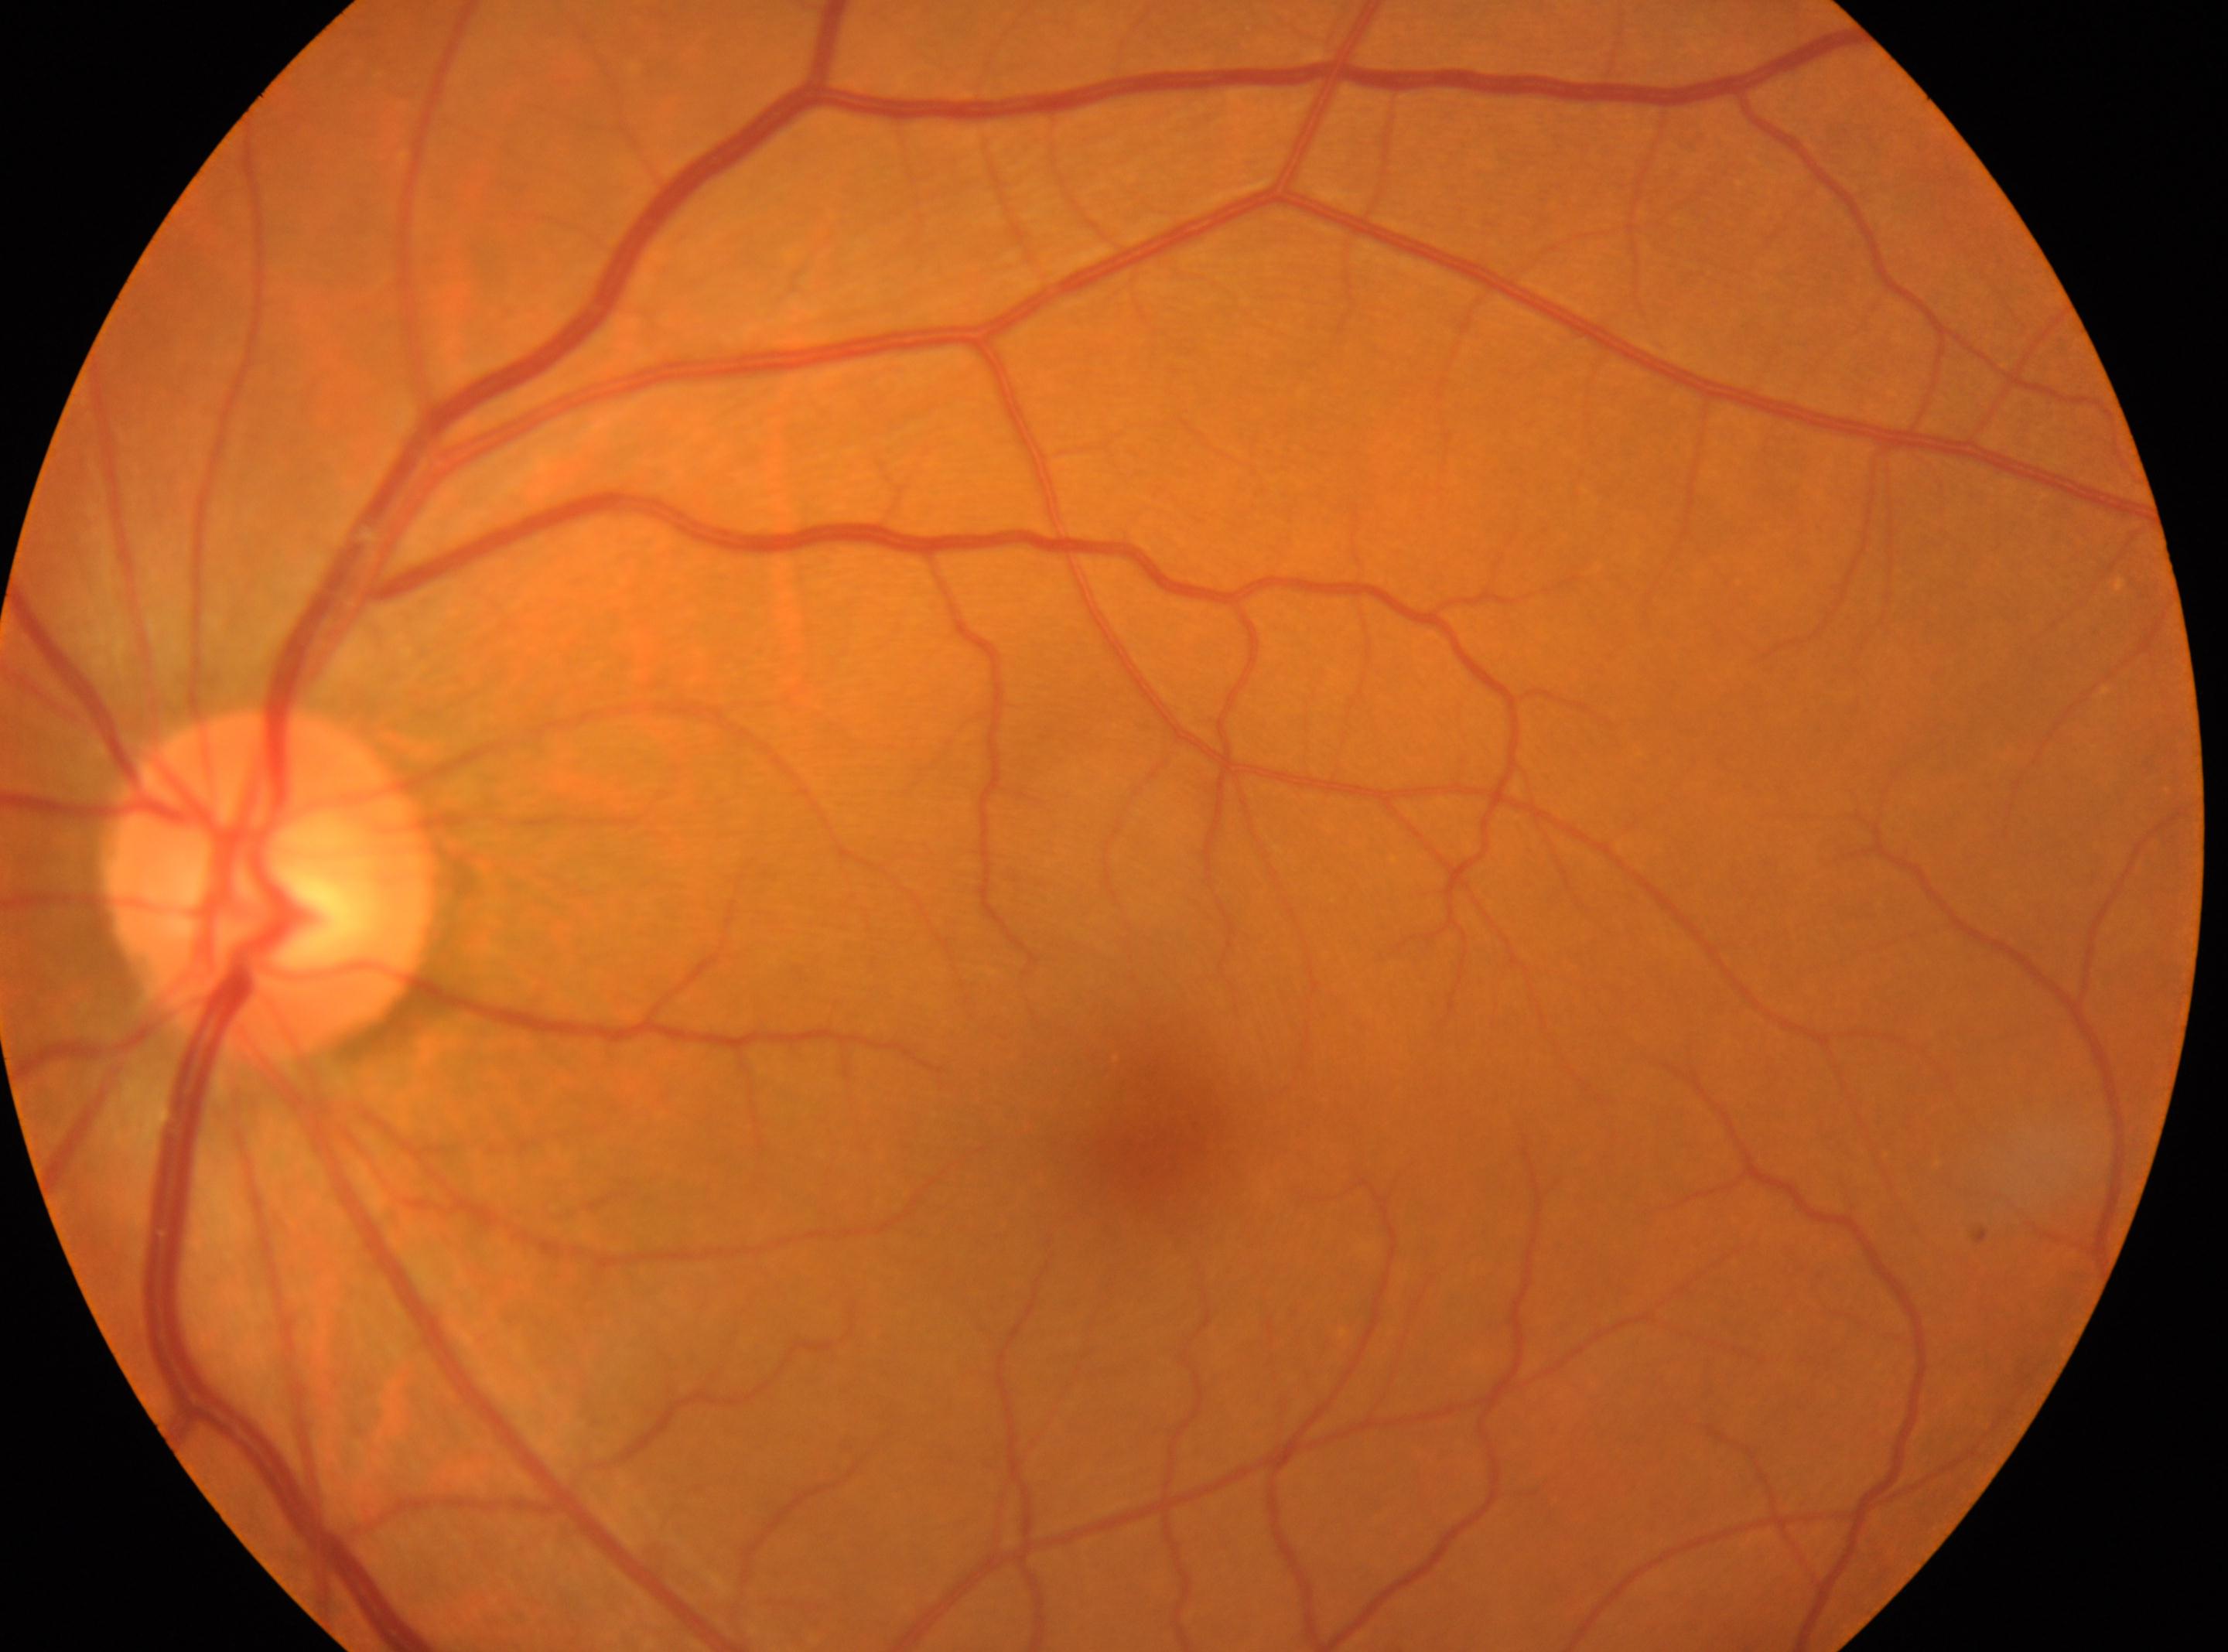
Diabetic retinopathy: no apparent retinopathy (grade 0). Eye: left. The disc center is at 270px, 886px. Foveal center located at 1146px, 1148px.